2352 x 1568 pixels: 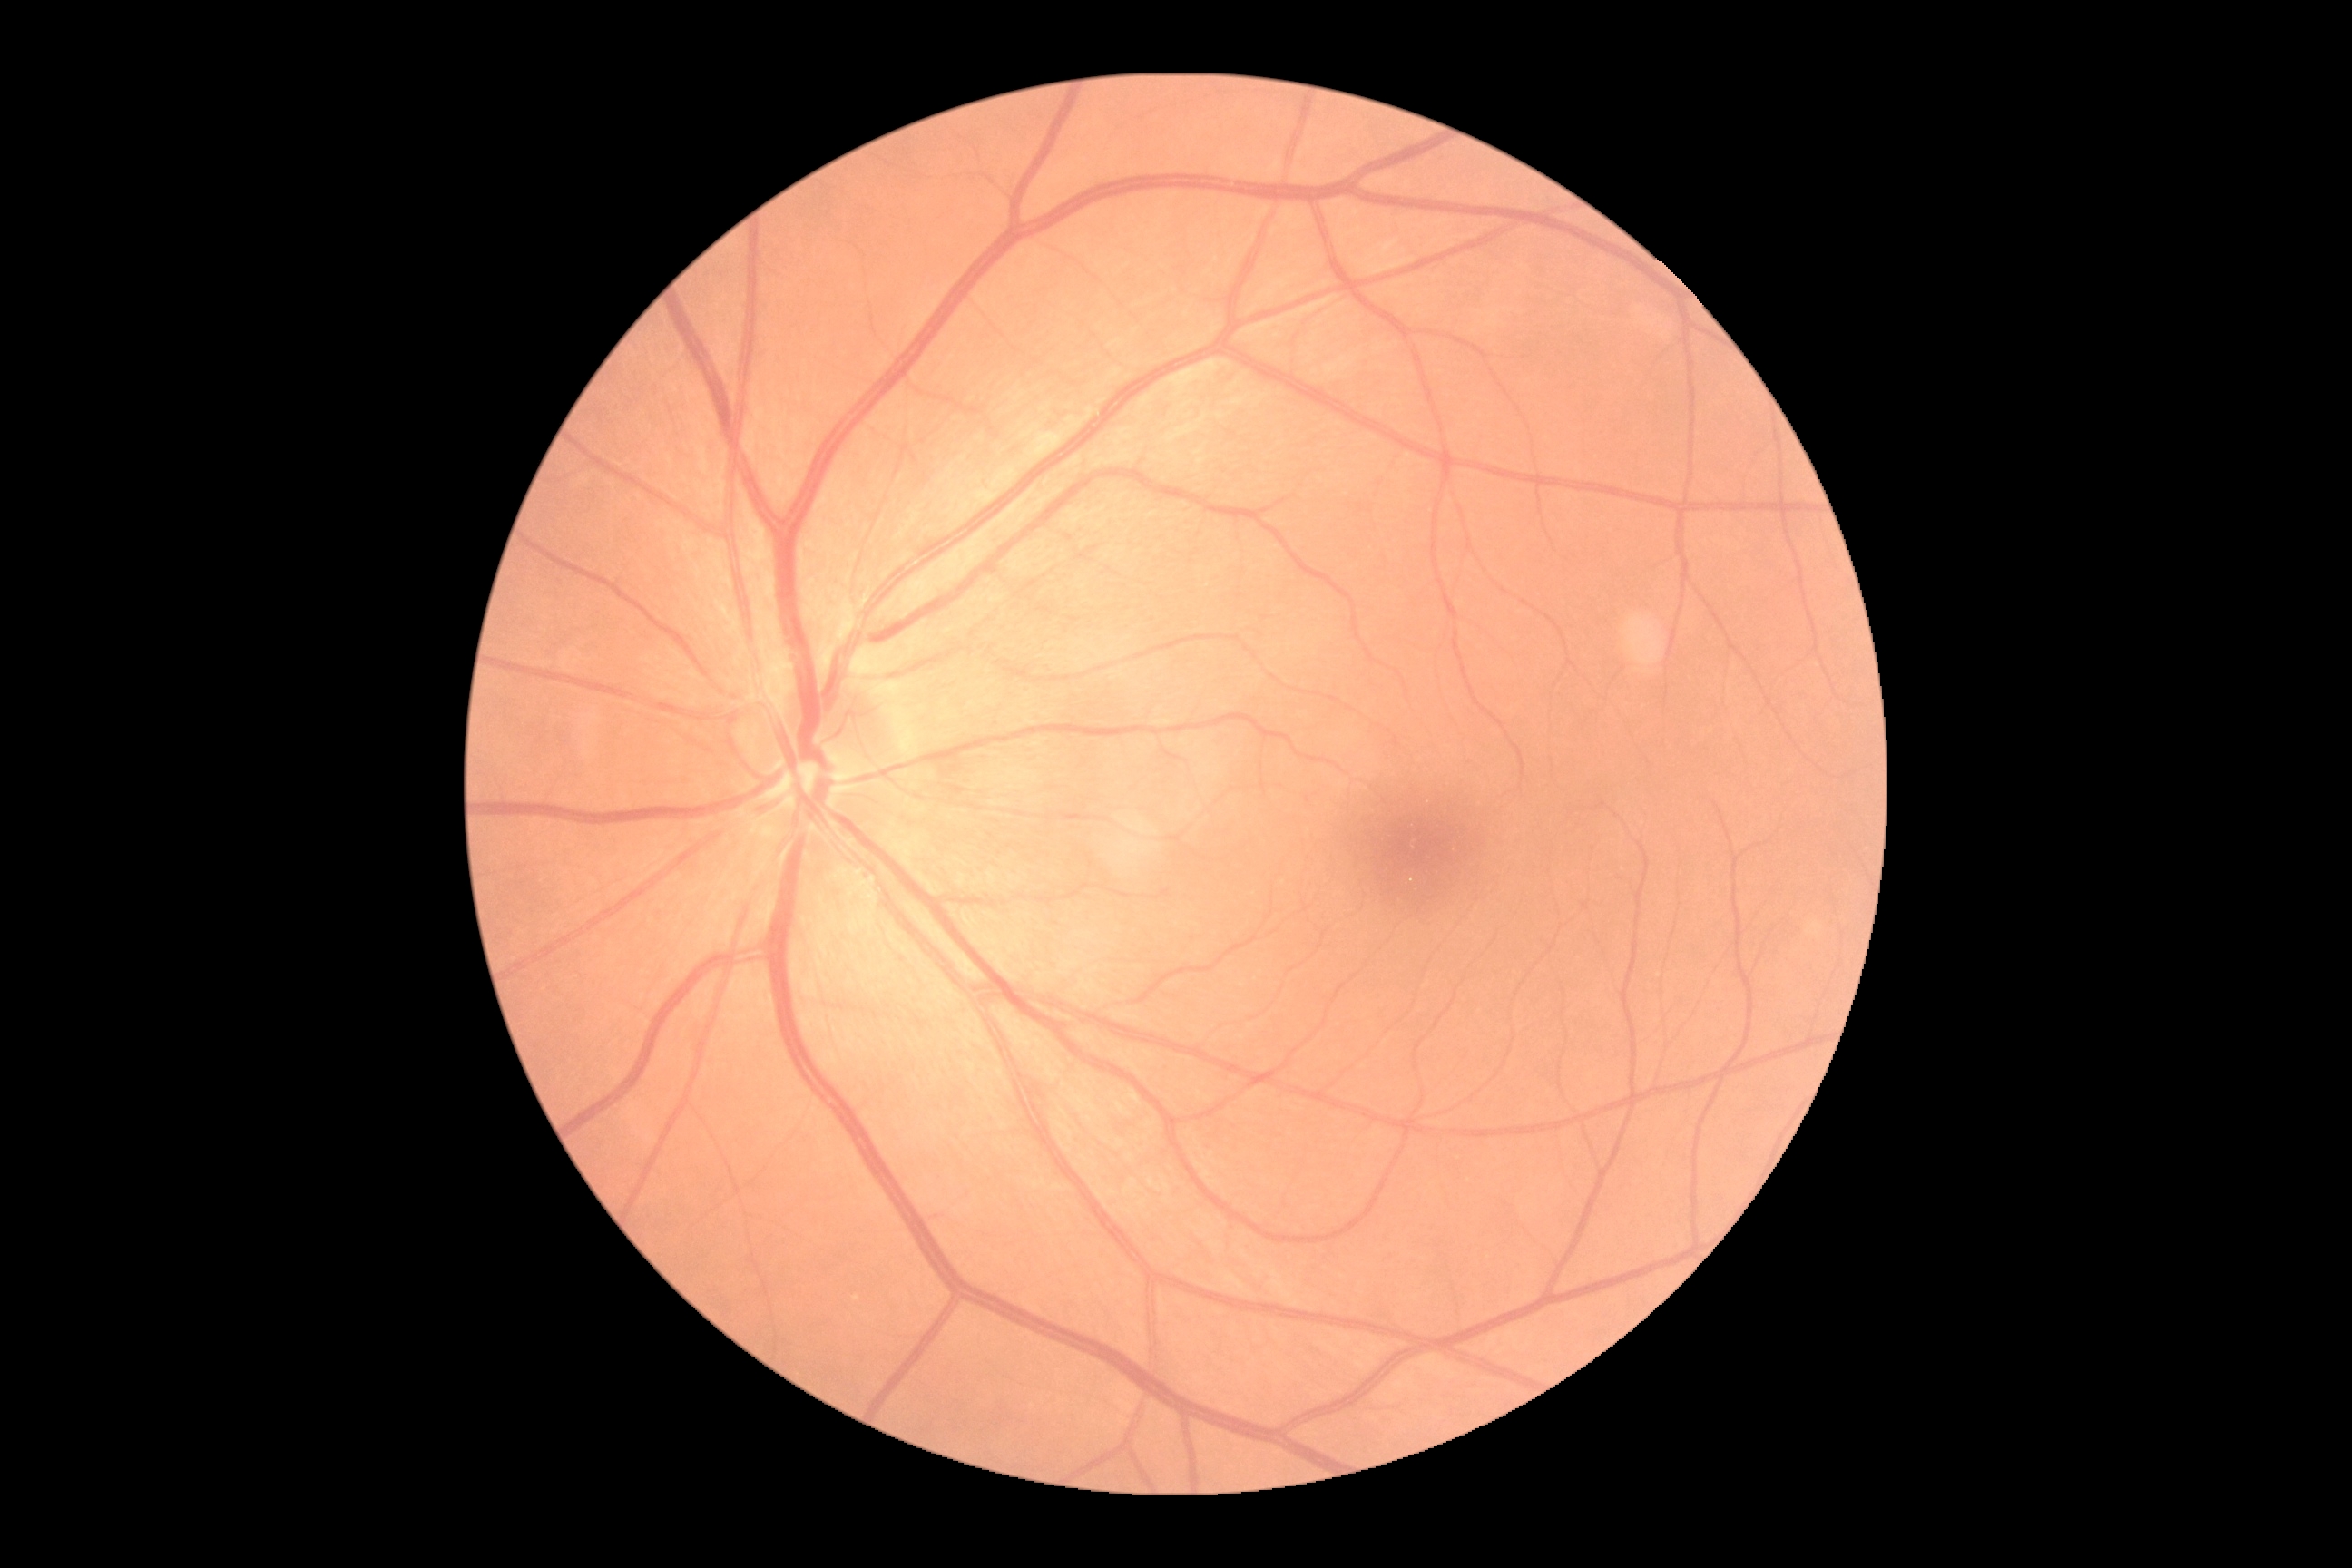 Findings:
- DR impression — negative for DR
- DR grade — 0